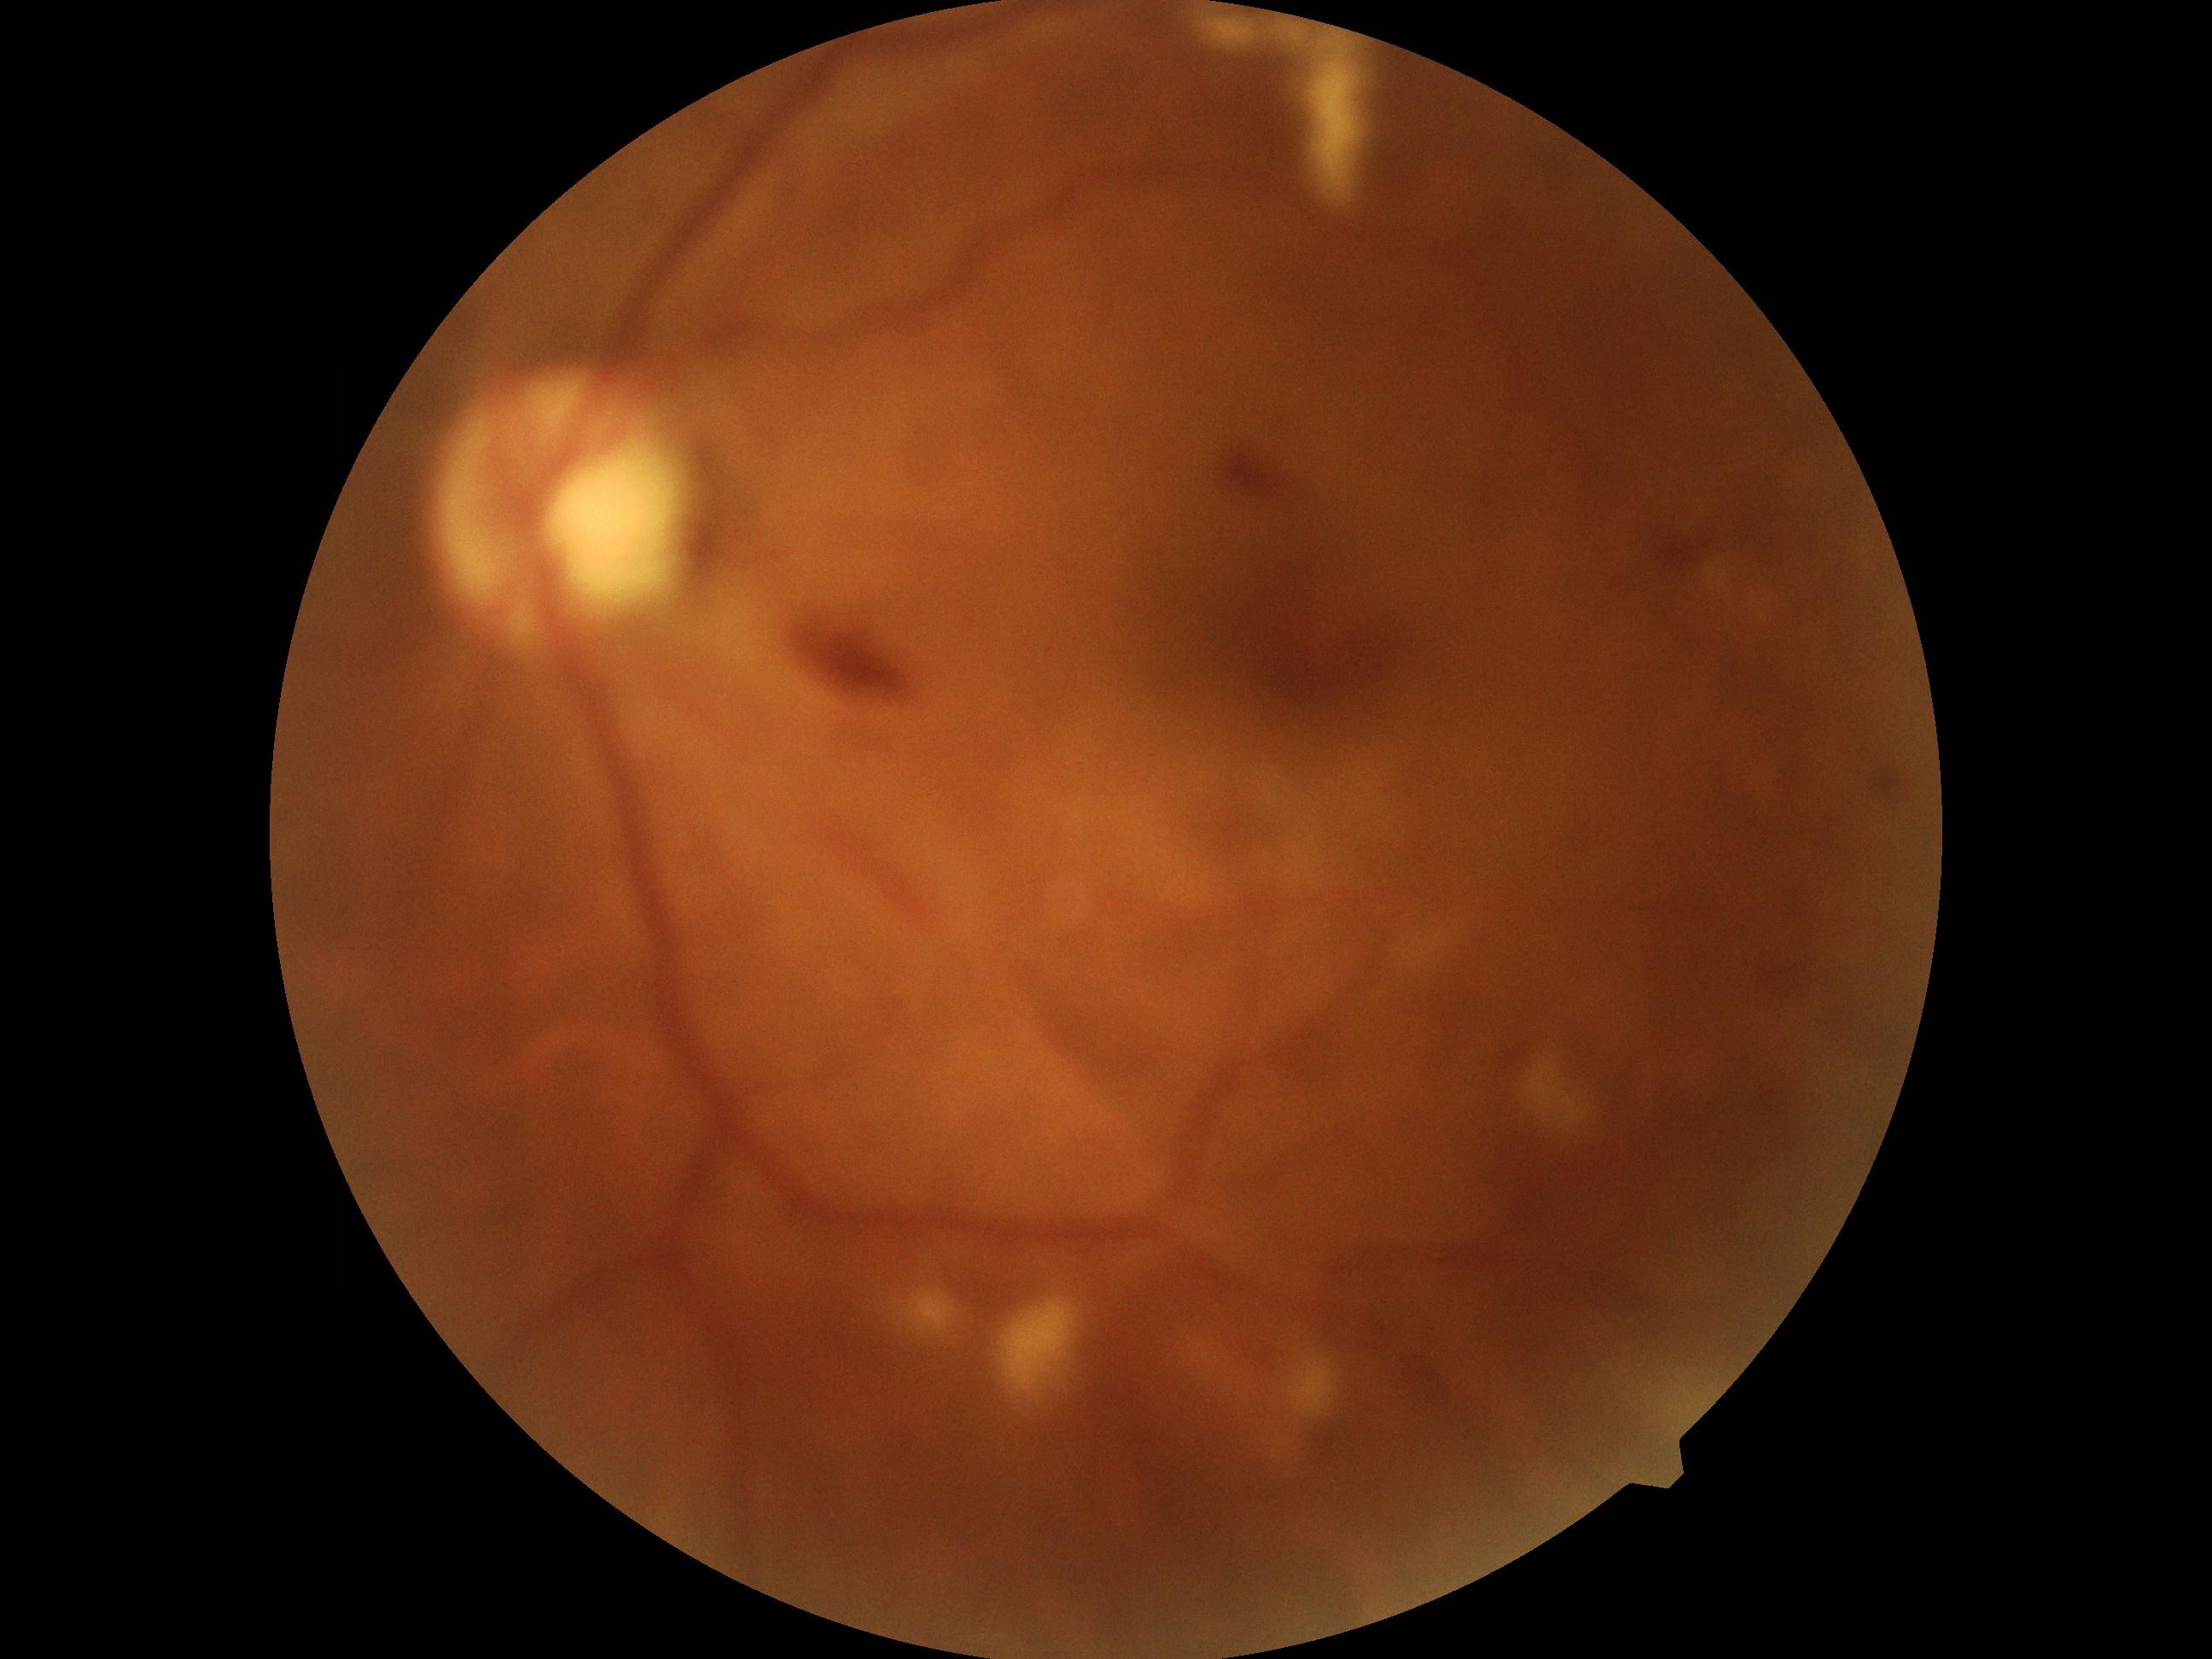

DR class: non-proliferative diabetic retinopathy.
DR grade: 2 (moderate NPDR) — more than just microaneurysms but less than severe NPDR.